1924 x 1556 pixels; ultra-widefield fundus photograph
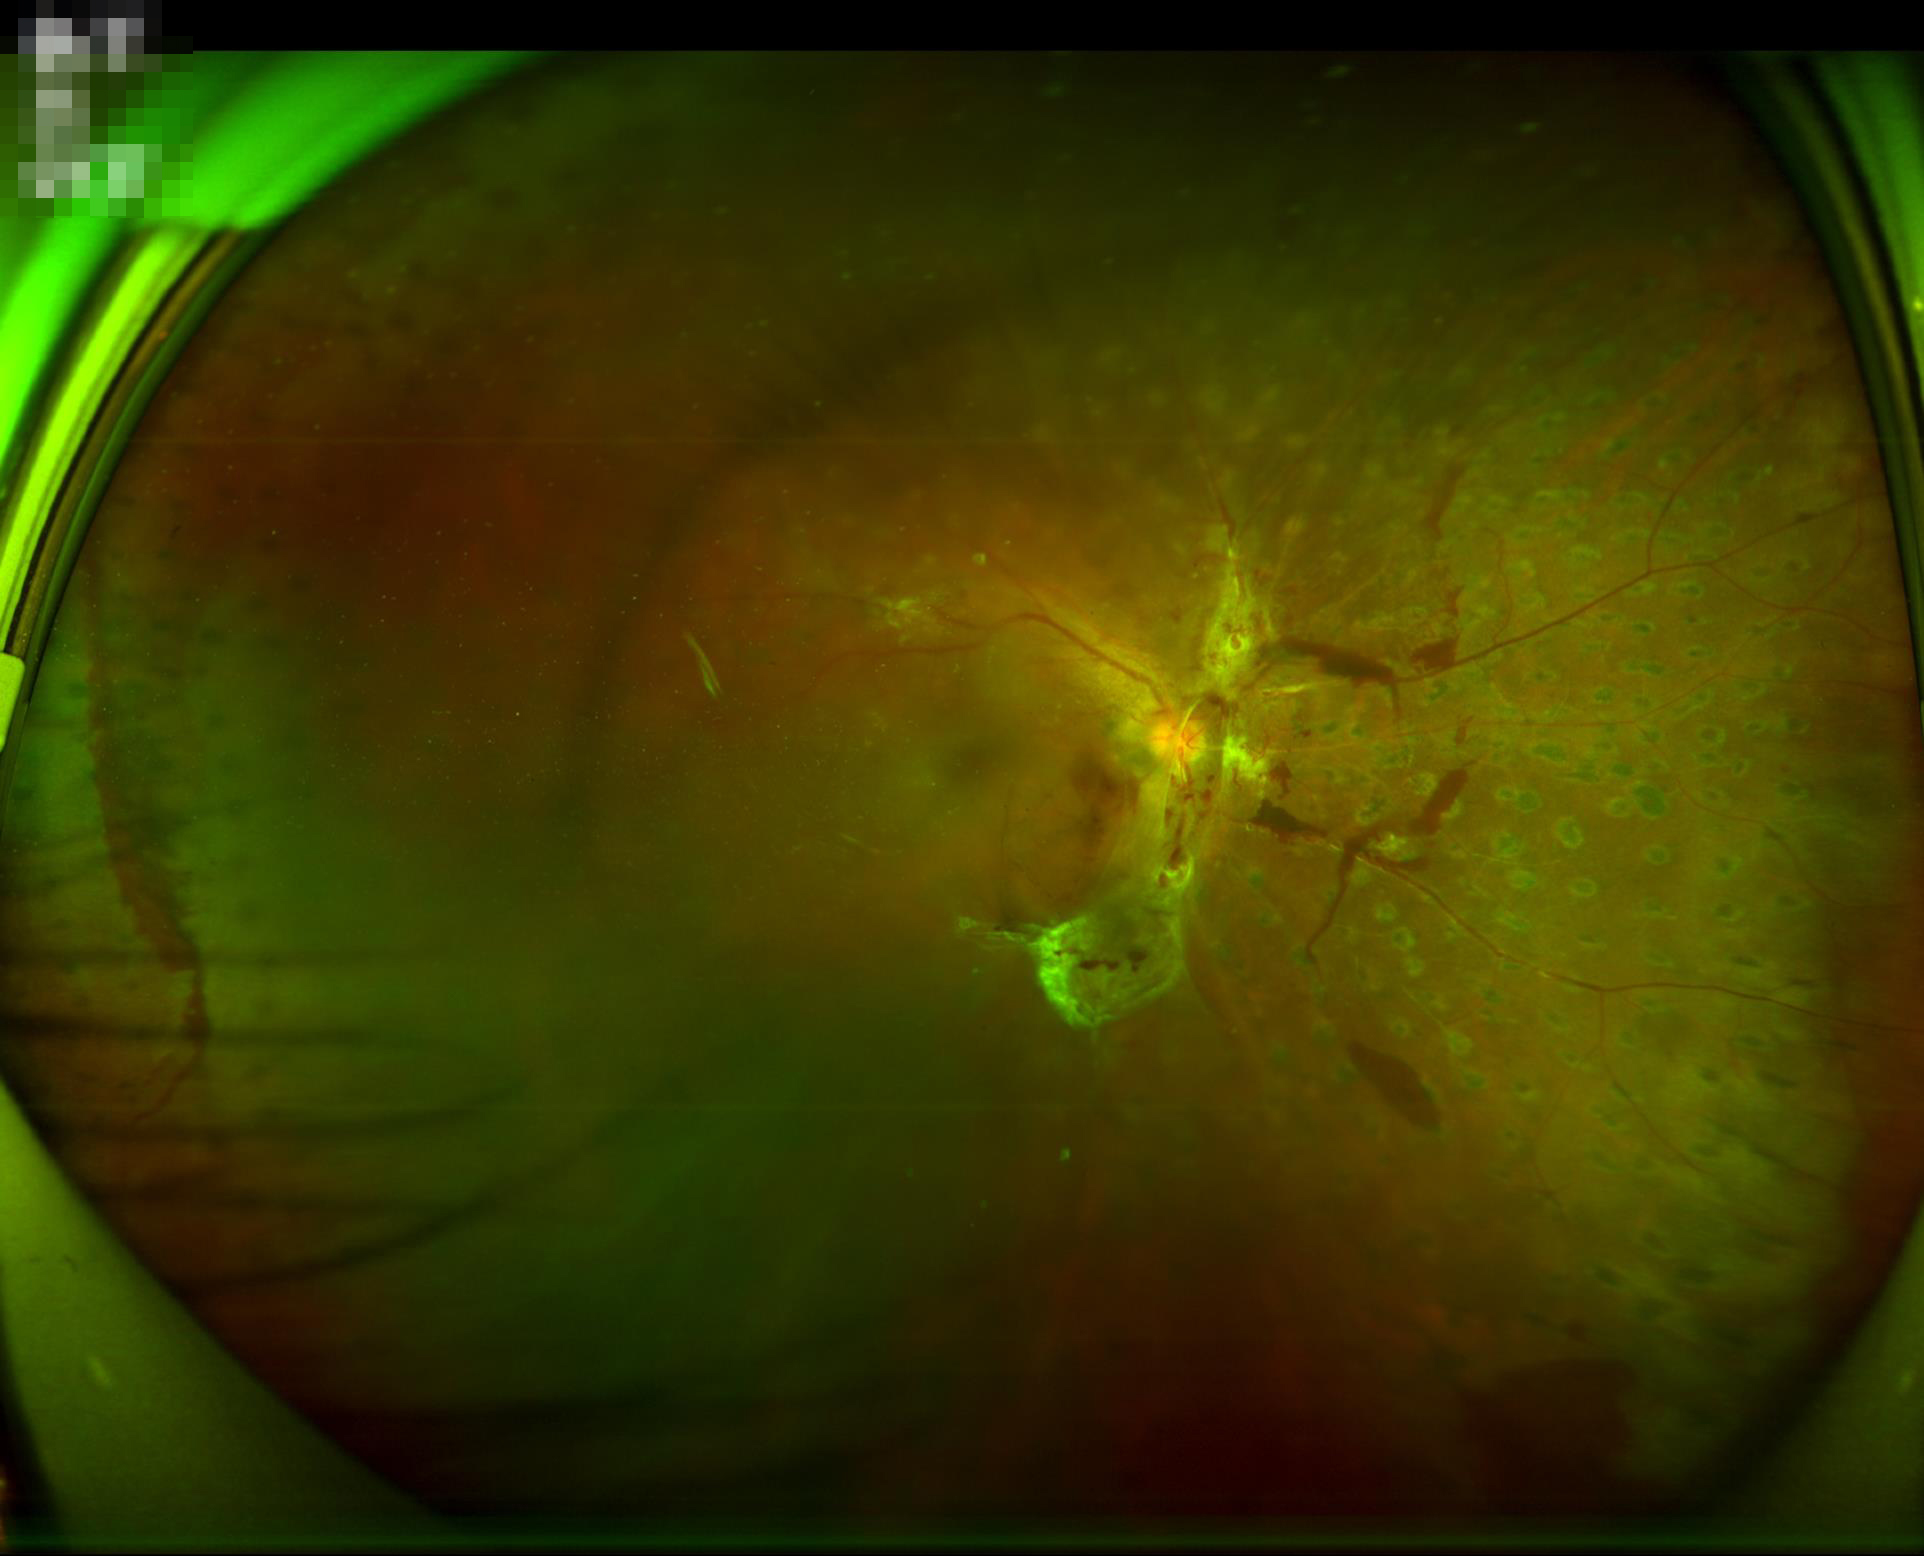
Quality assessment:
- illumination: no over- or under-exposure
- overall: poor, ungradable
- clarity: noticeable blur in the optic disc, vessels, or background